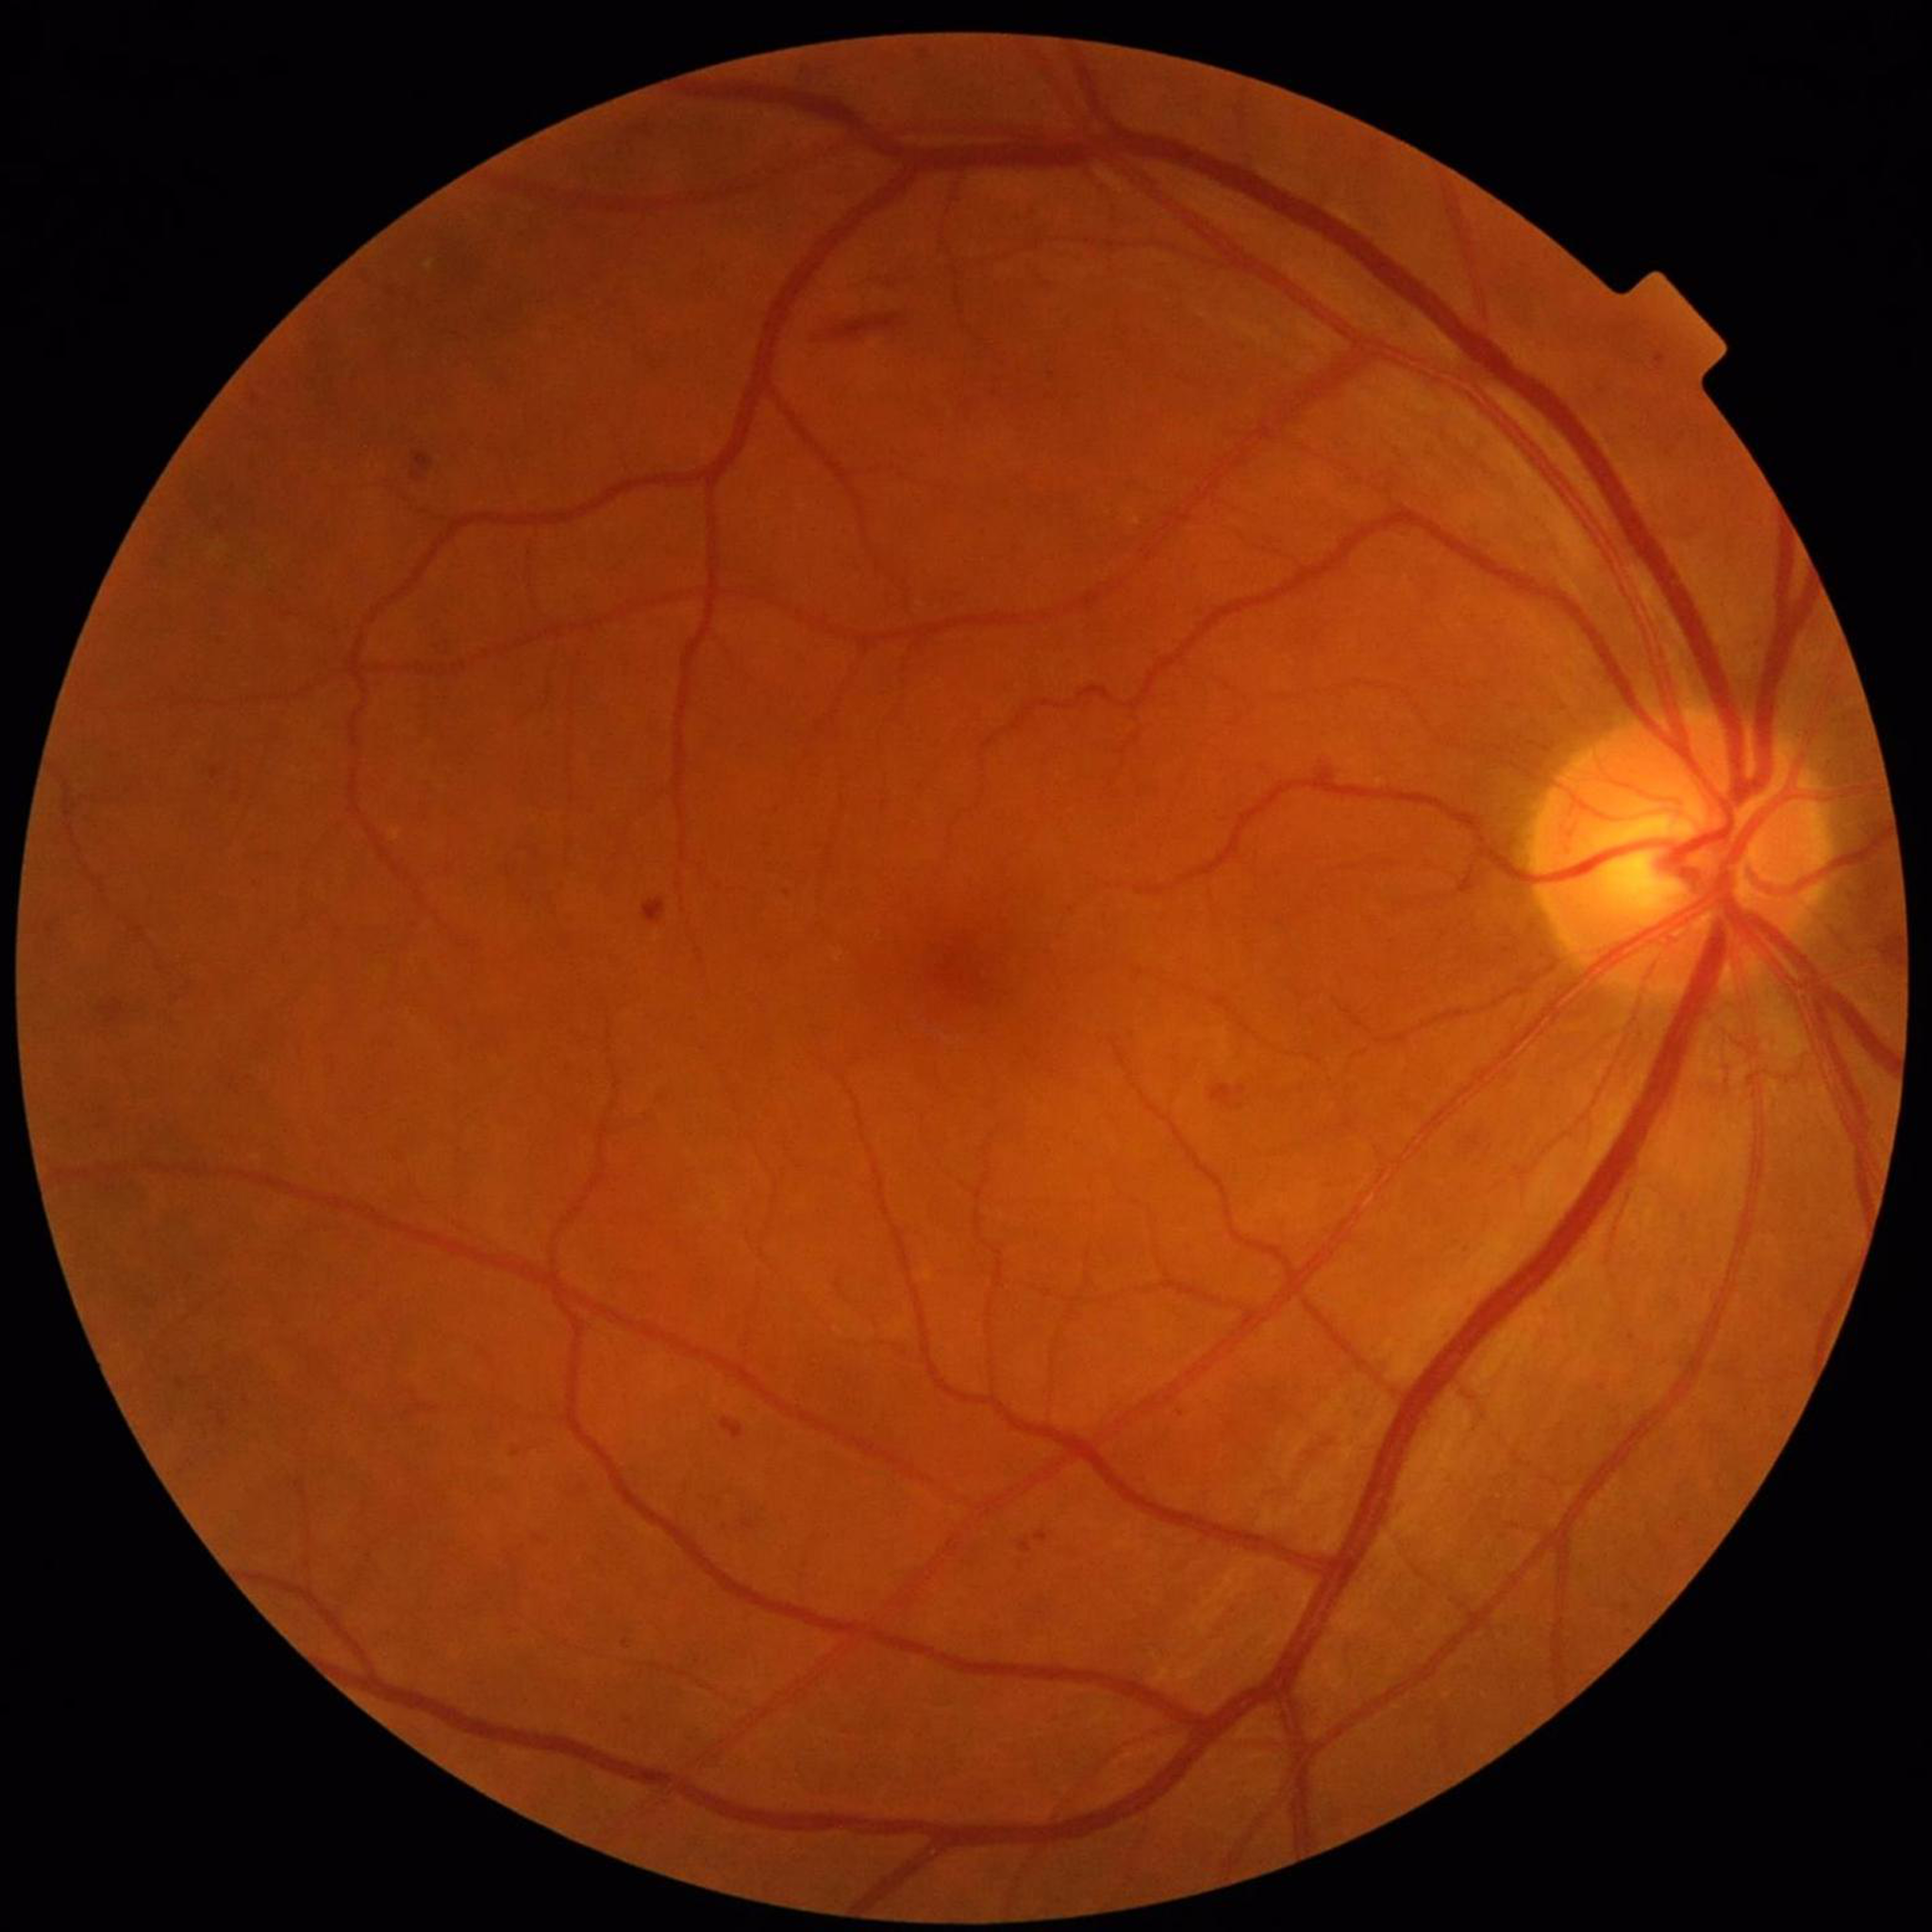 Impression: diabetic retinopathy; Quality assessment: contrast adequate, illumination and color satisfactory, no blur.